Image size 848x848. Without pupil dilation. 45° FOV. Posterior pole photograph: 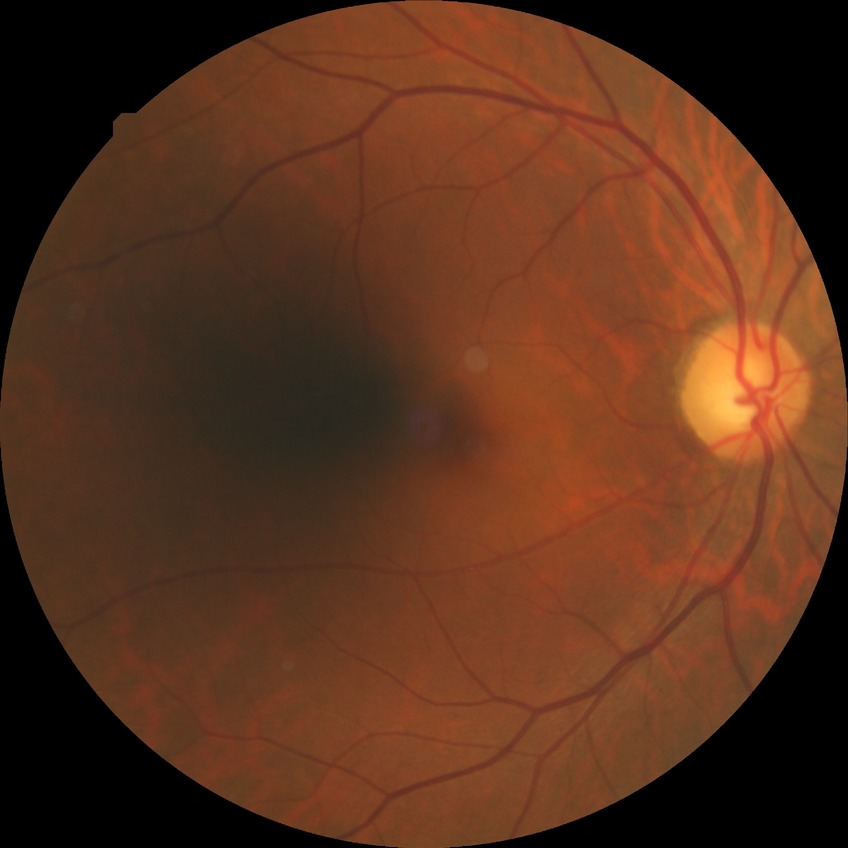
Diabetic retinopathy (DR) is no diabetic retinopathy (NDR).